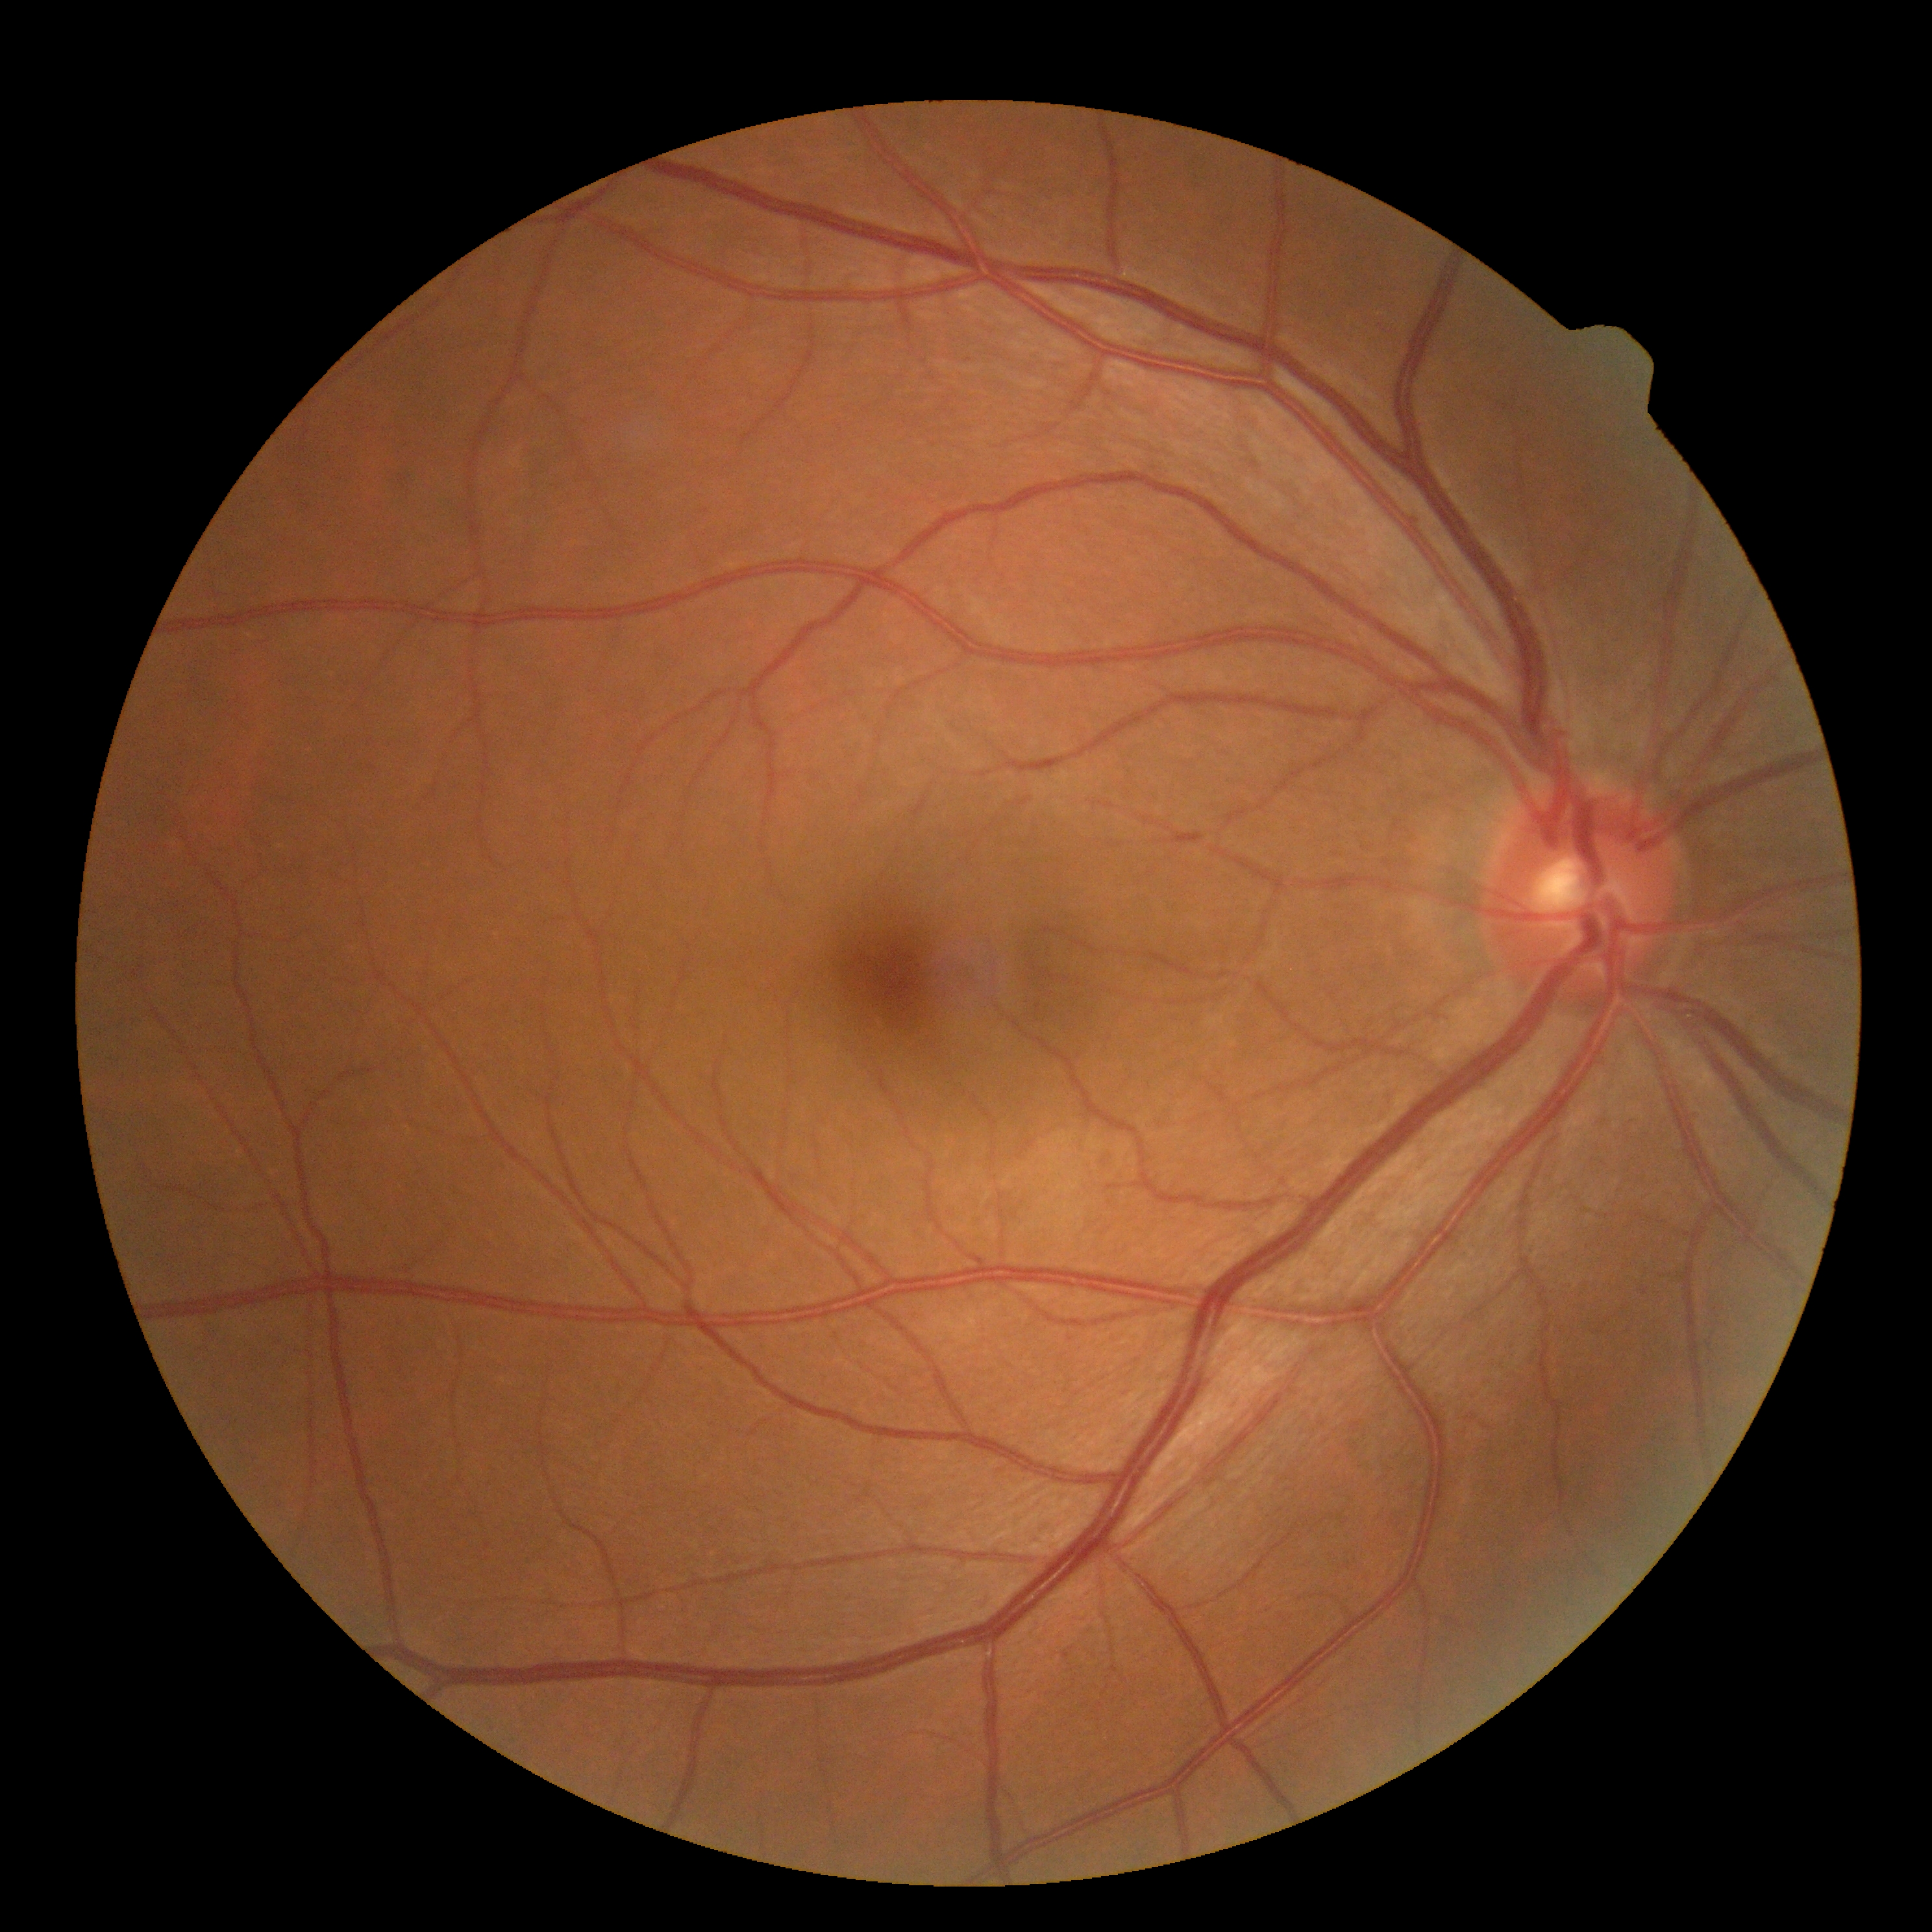
Diabetic retinopathy: grade 0 (no apparent retinopathy) — no visible signs of diabetic retinopathy.